Graded on the modified Davis scale — 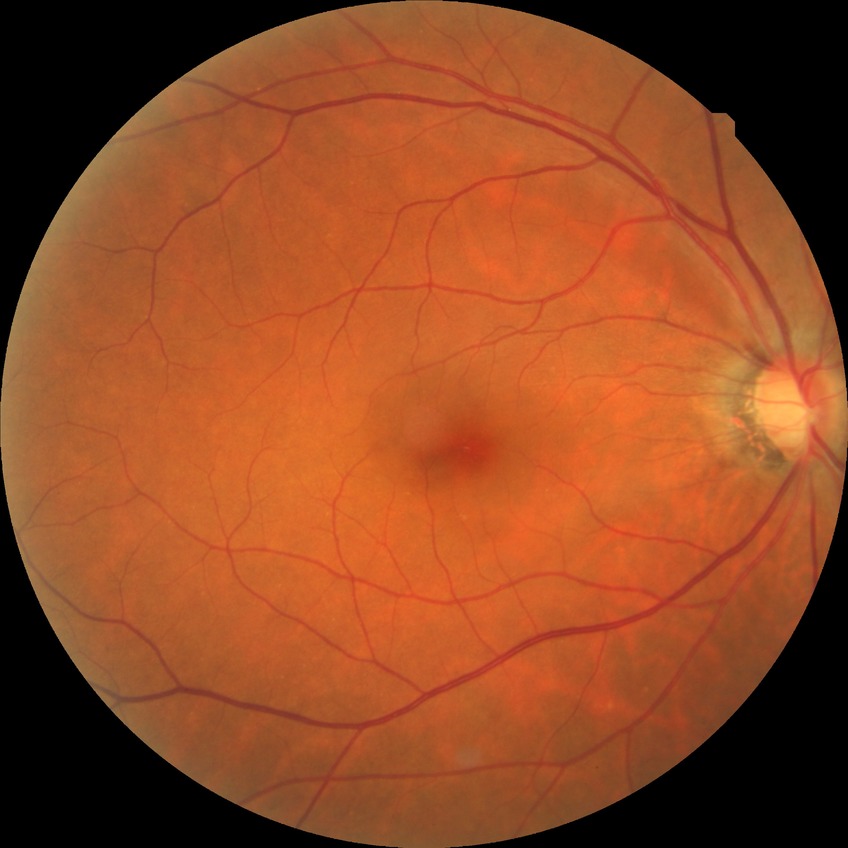
Diabetic retinopathy (DR) is no diabetic retinopathy (NDR).